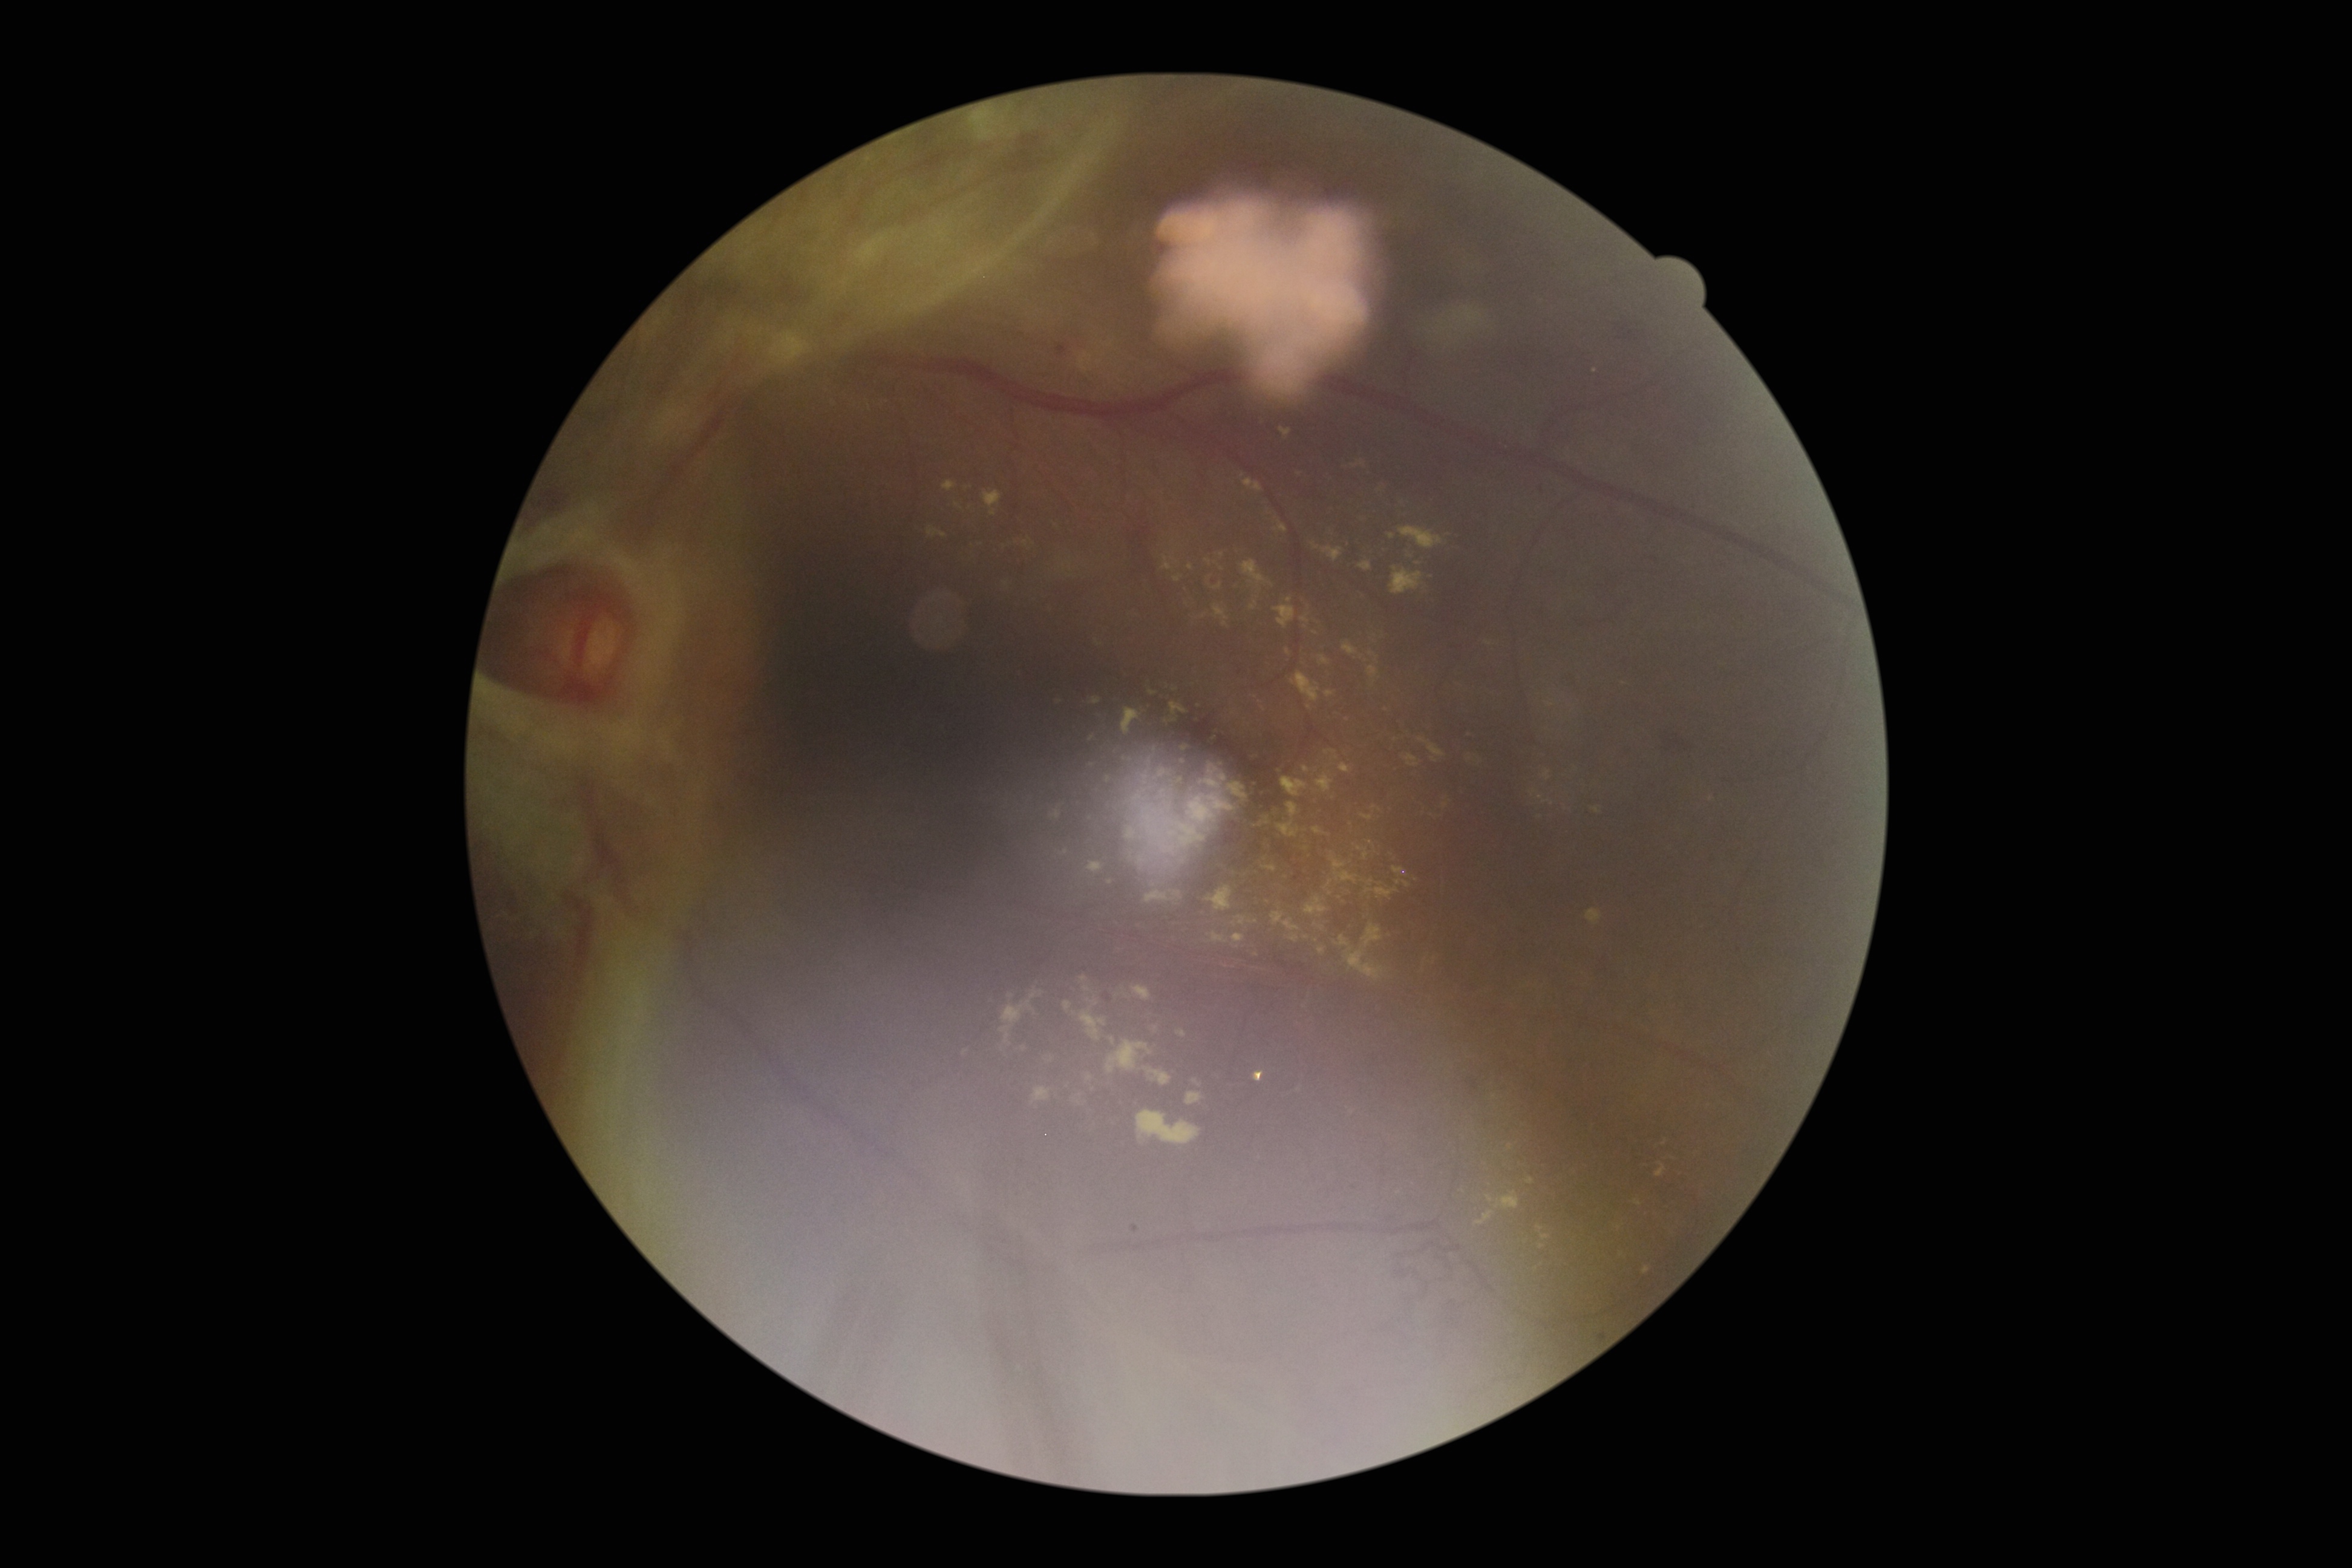
DR severity: grade 4 (PDR) — neovascularization and/or vitreous/pre-retinal hemorrhage; proliferative diabetic retinopathy
Selected lesions:
EXs (more not shown): [1495, 1192, 1520, 1210] | [1250, 602, 1258, 610] | [1342, 643, 1359, 655] | [1214, 927, 1226, 937] | [1233, 909, 1255, 925] | [1075, 969, 1105, 1046] | [1593, 808, 1601, 814] | [1315, 647, 1336, 673] | [1325, 750, 1338, 760] | [1313, 622, 1327, 639] | [1242, 561, 1273, 587] | [1166, 705, 1187, 722] | [1120, 757, 1133, 764] | [1475, 1212, 1495, 1226] | [1156, 769, 1171, 780]
Smaller EXs around 1469, 759 | 1418, 564 | 1637, 1203